Captured on a Nidek AFC-330 fundus camera. Captured without pupil dilation:
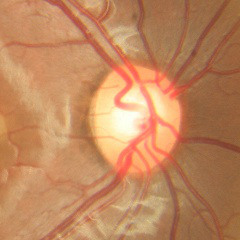 Assessment = no evidence of glaucoma.